FOV: 45 degrees
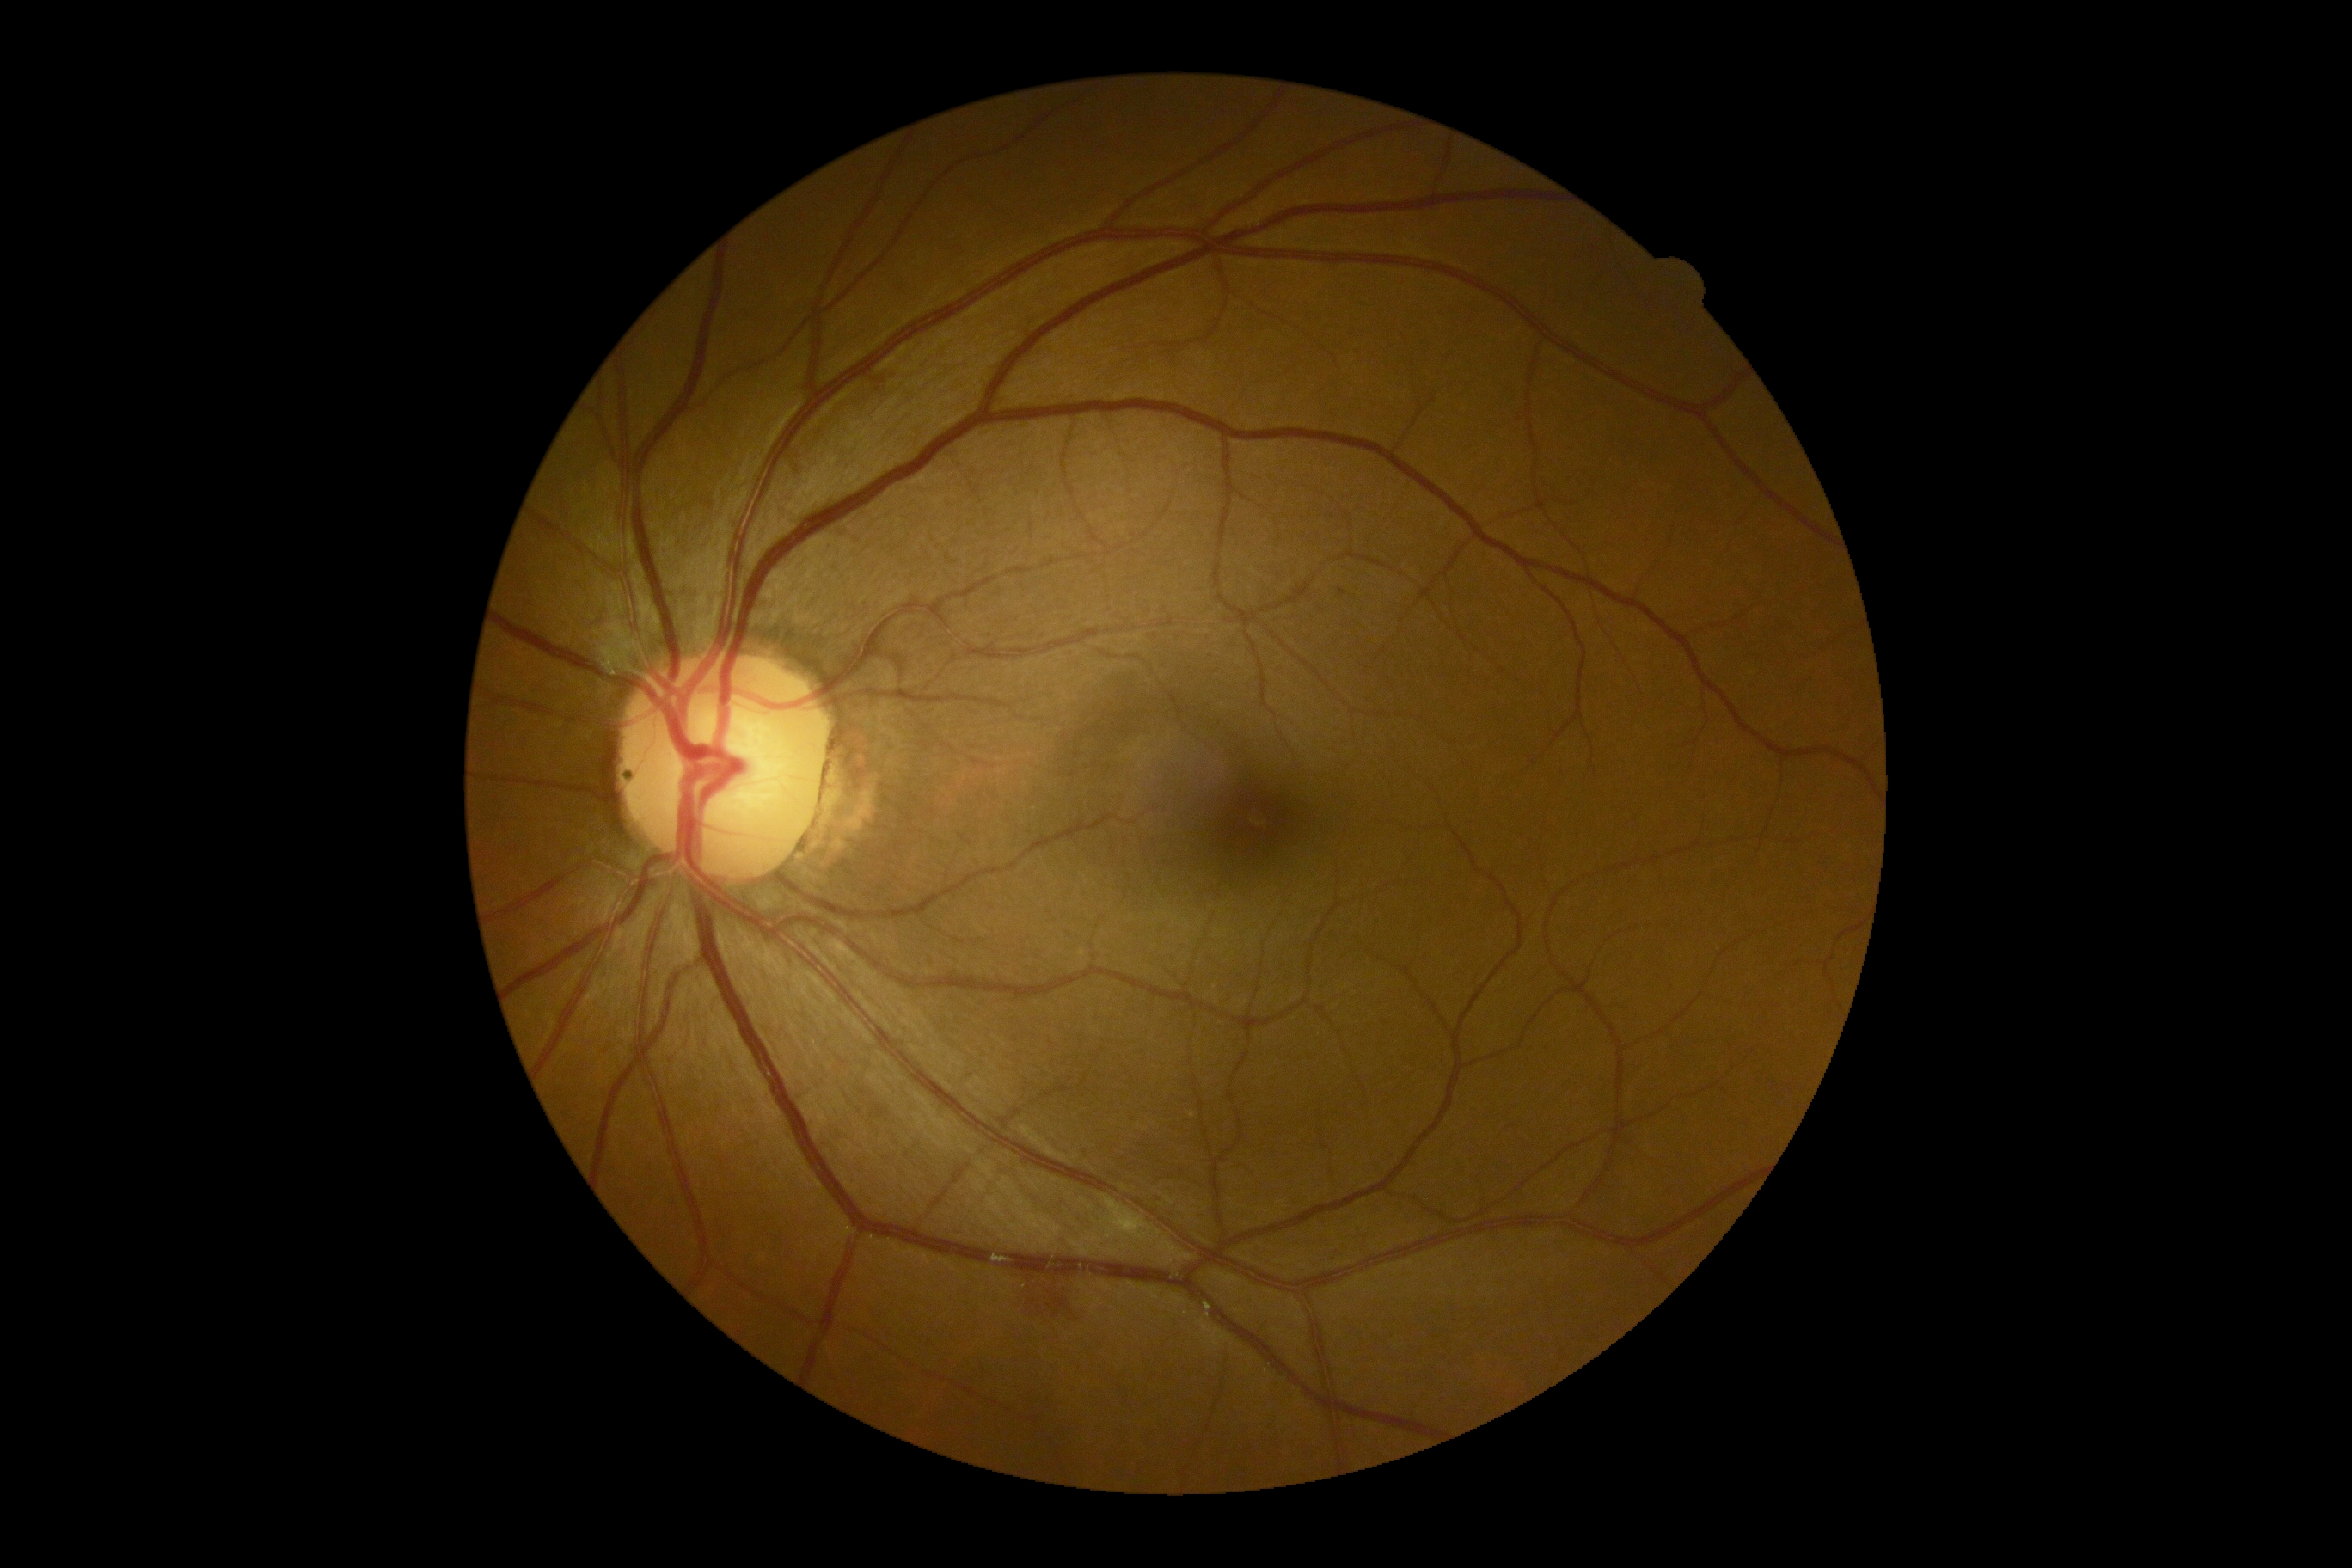

Diabetic retinopathy (DR) is moderate NPDR (grade 2) — more than just microaneurysms but less than severe NPDR.